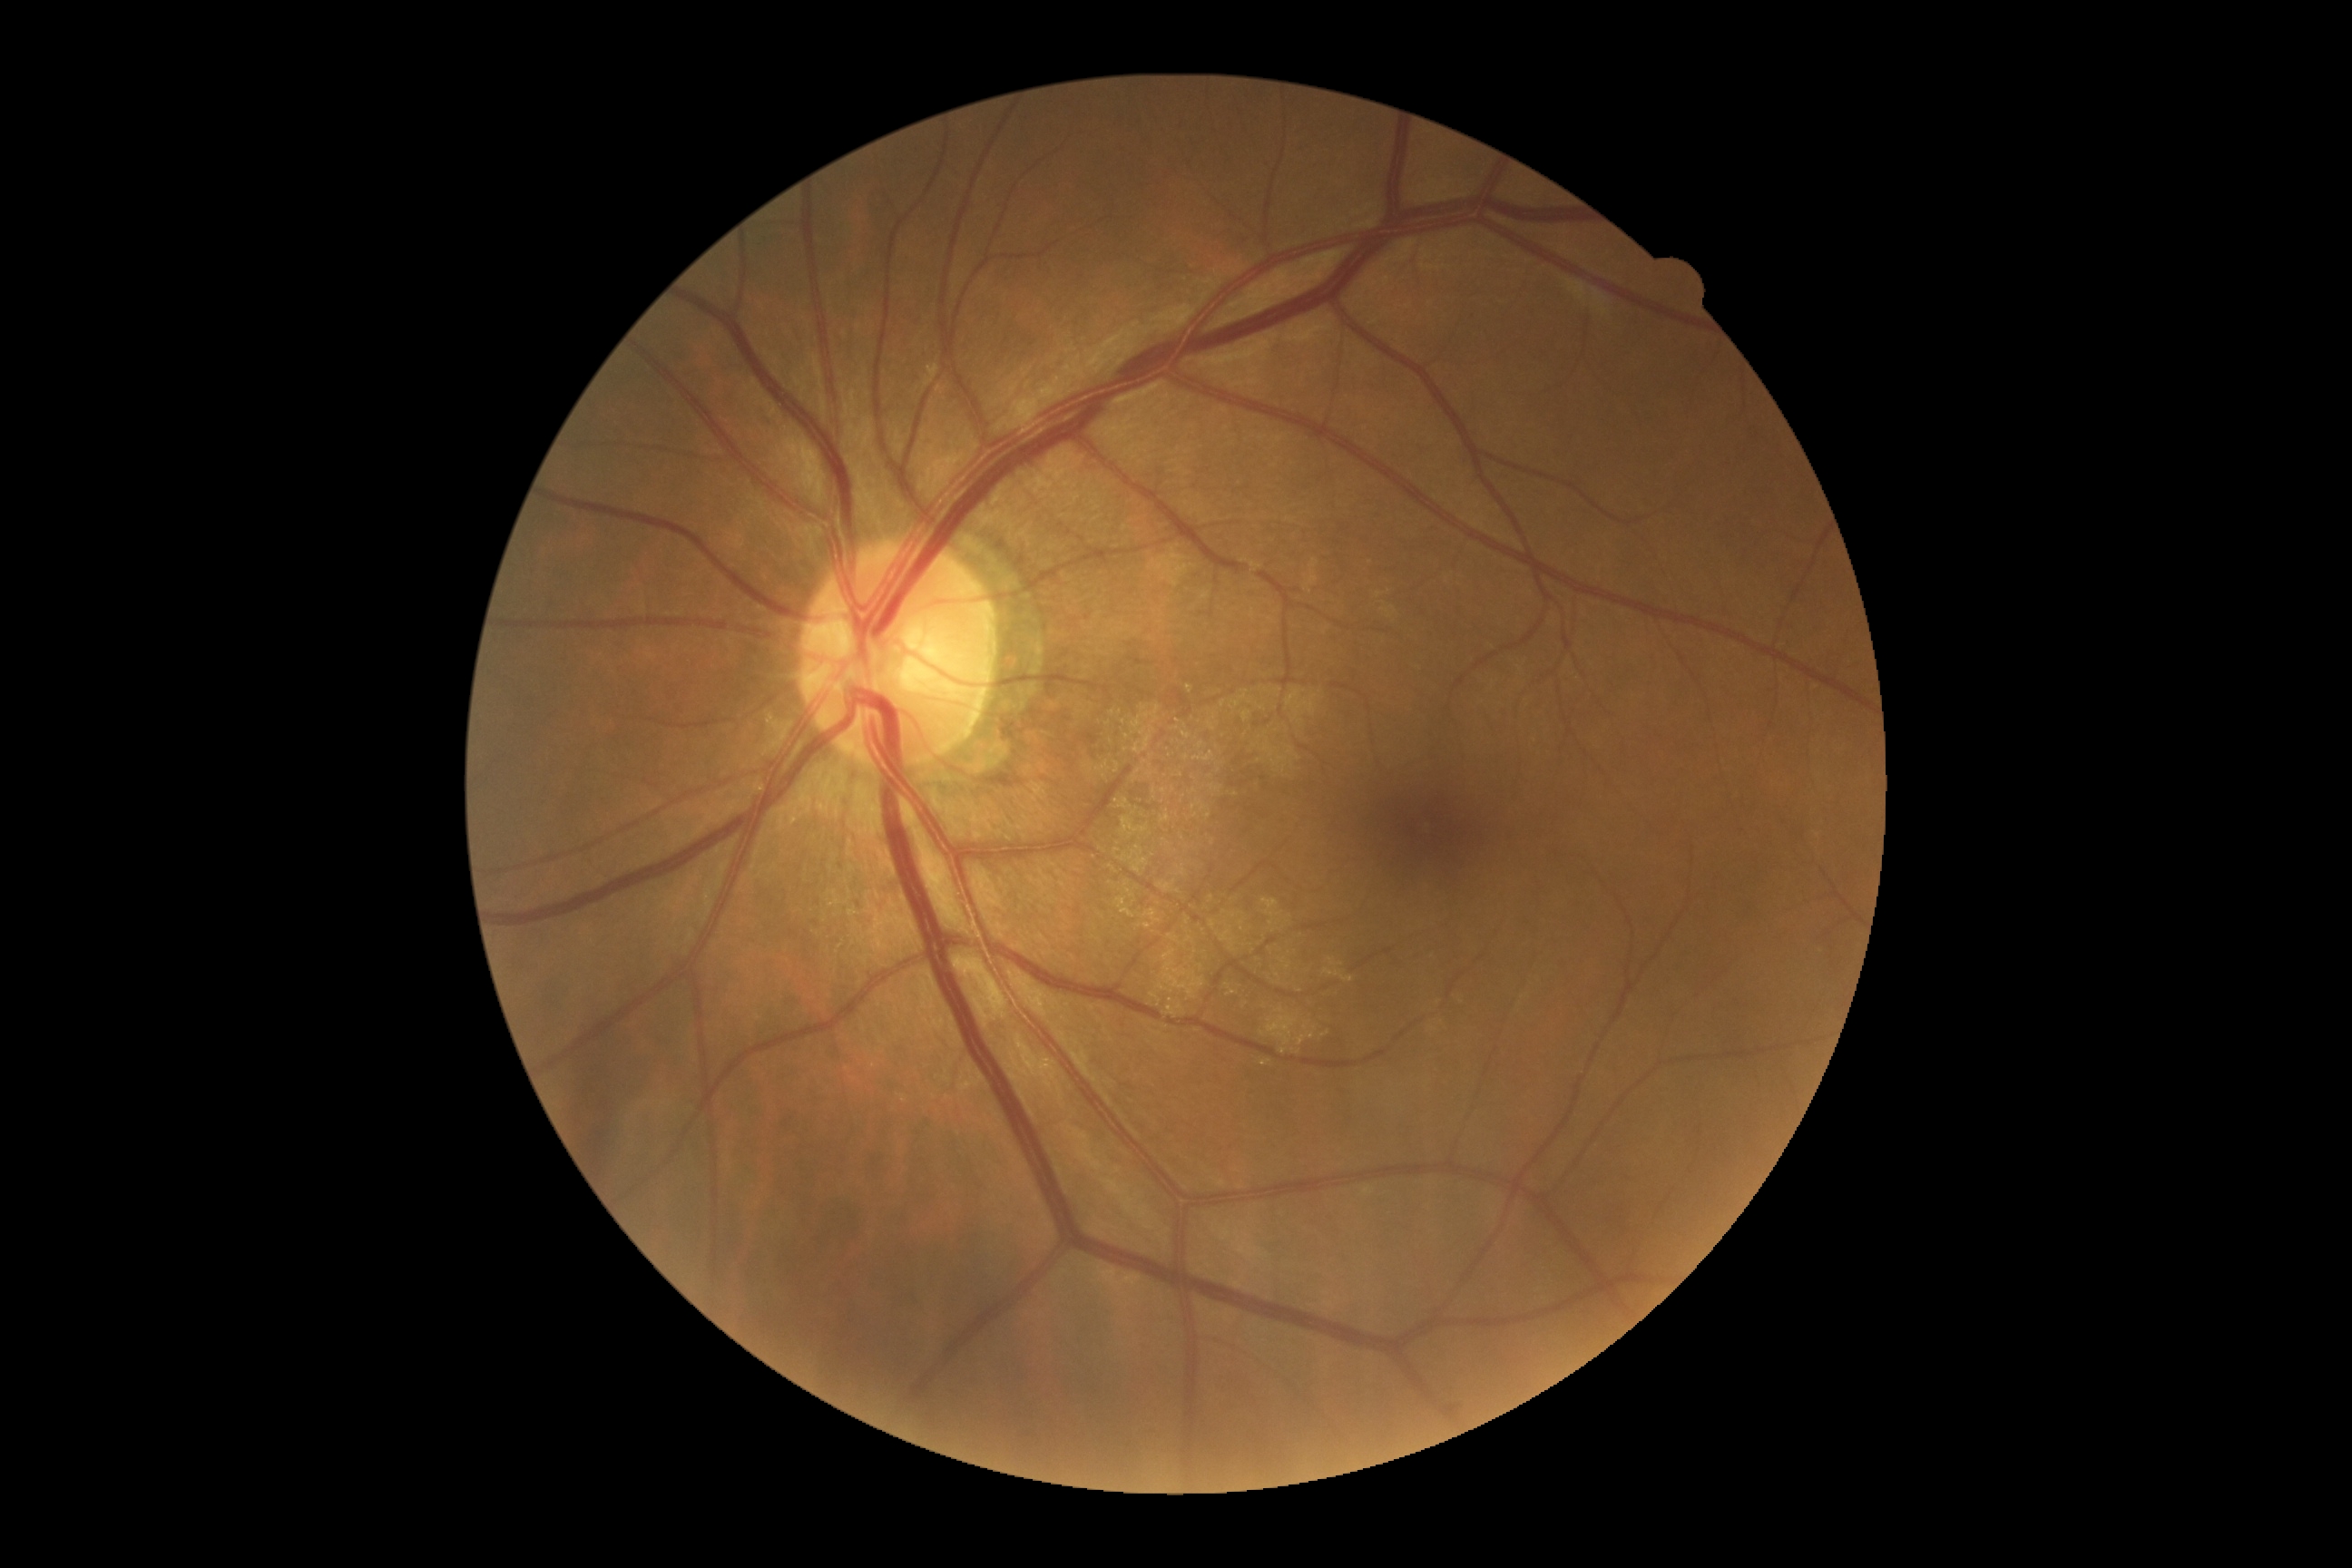 DR impression = no DR findings
DR = grade 0 (no apparent retinopathy)